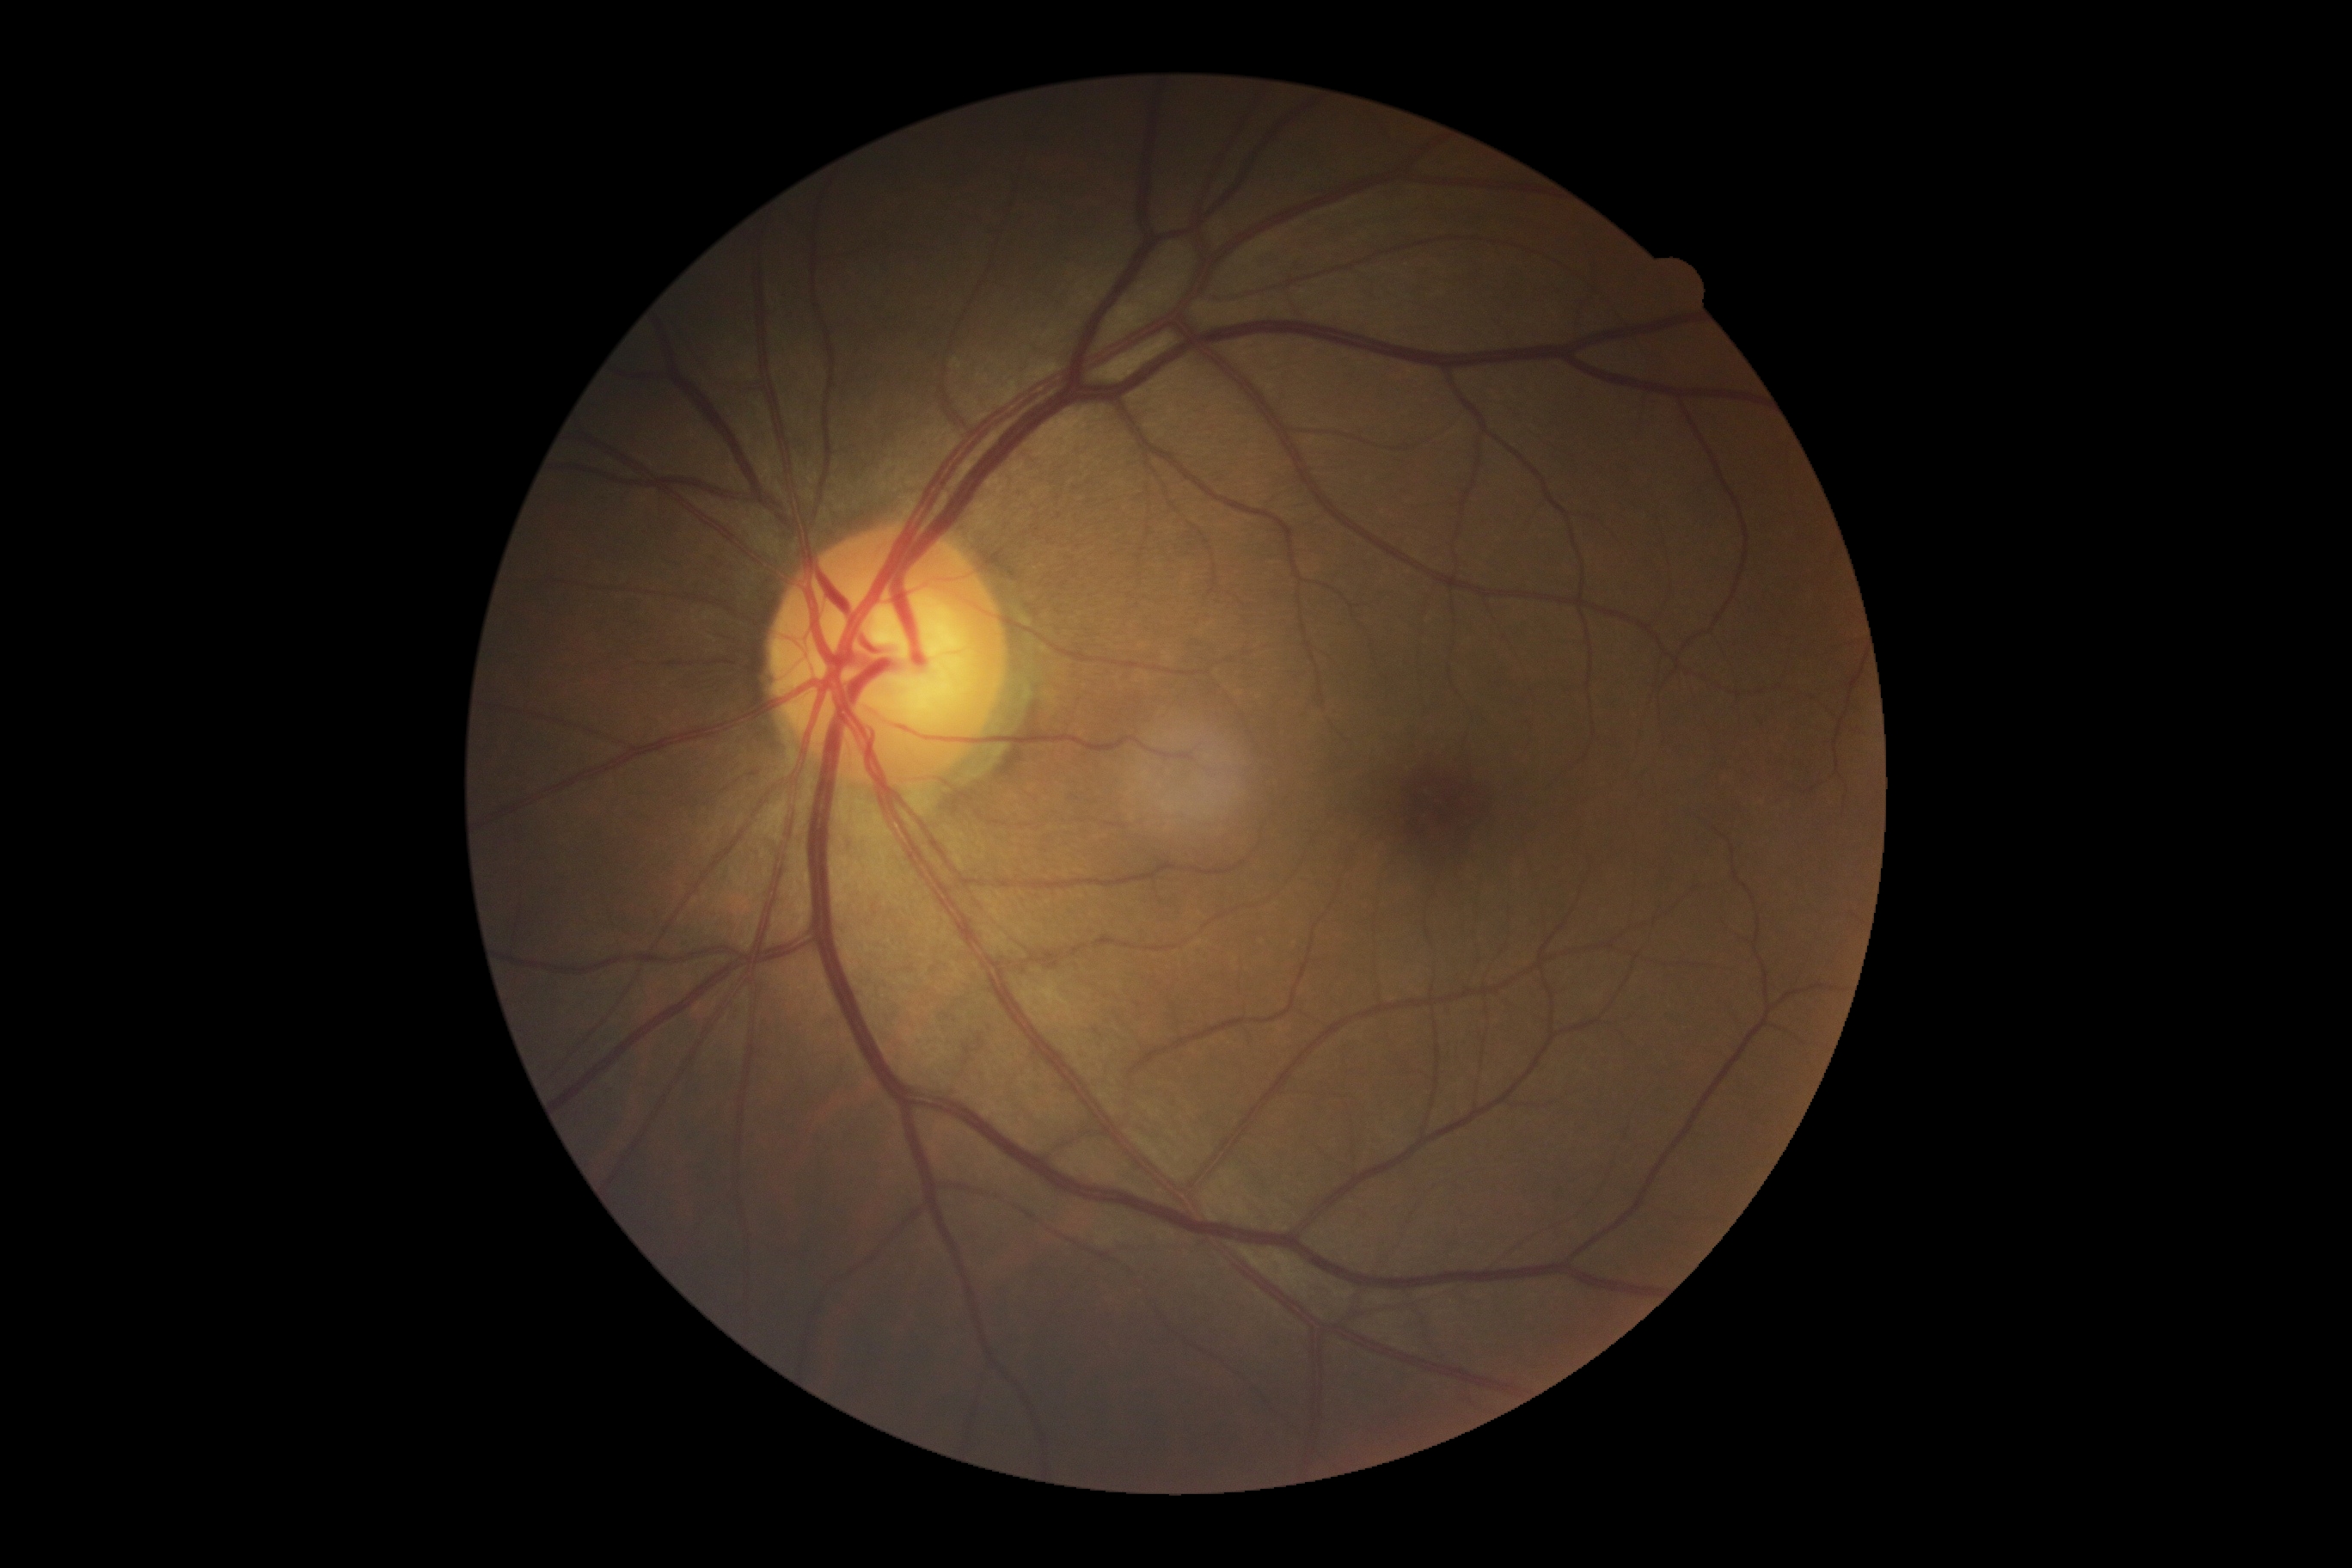 Findings:
• DR: no apparent diabetic retinopathy (grade 0) — no visible signs of diabetic retinopathy